2352 by 1568 pixels
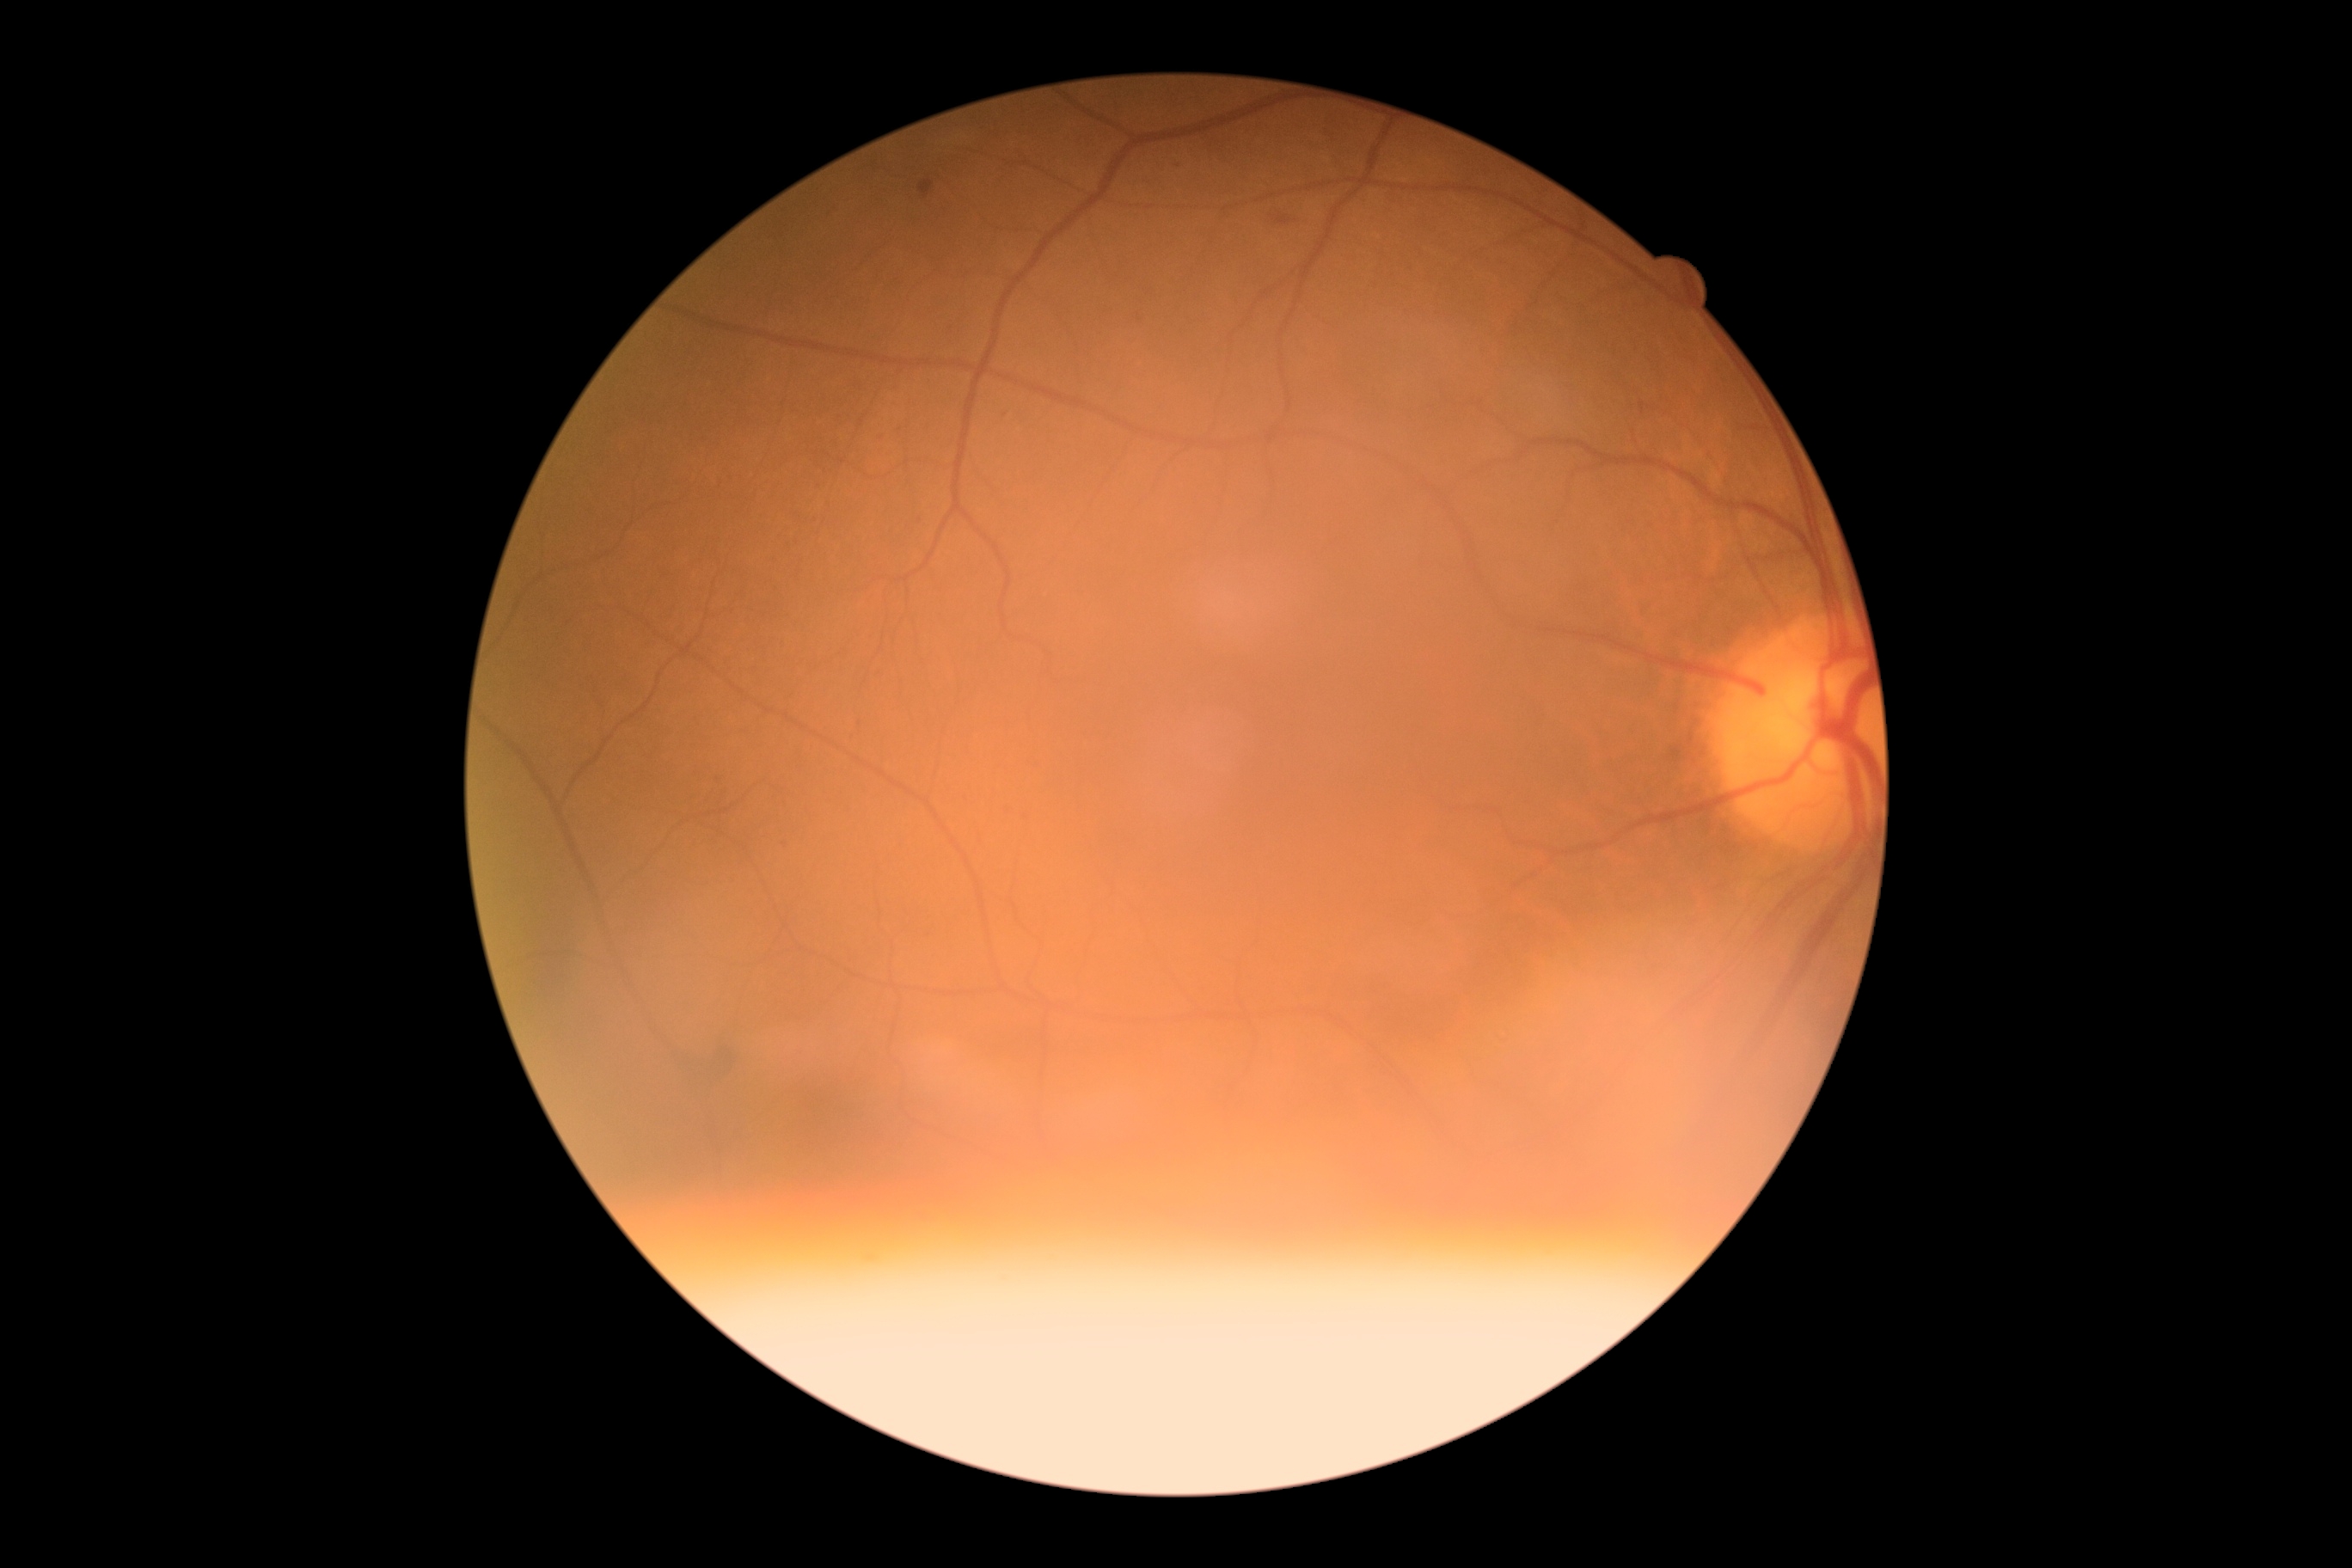
Annotations:
• diabetic retinopathy (DR): moderate non-proliferative diabetic retinopathy (grade 2)